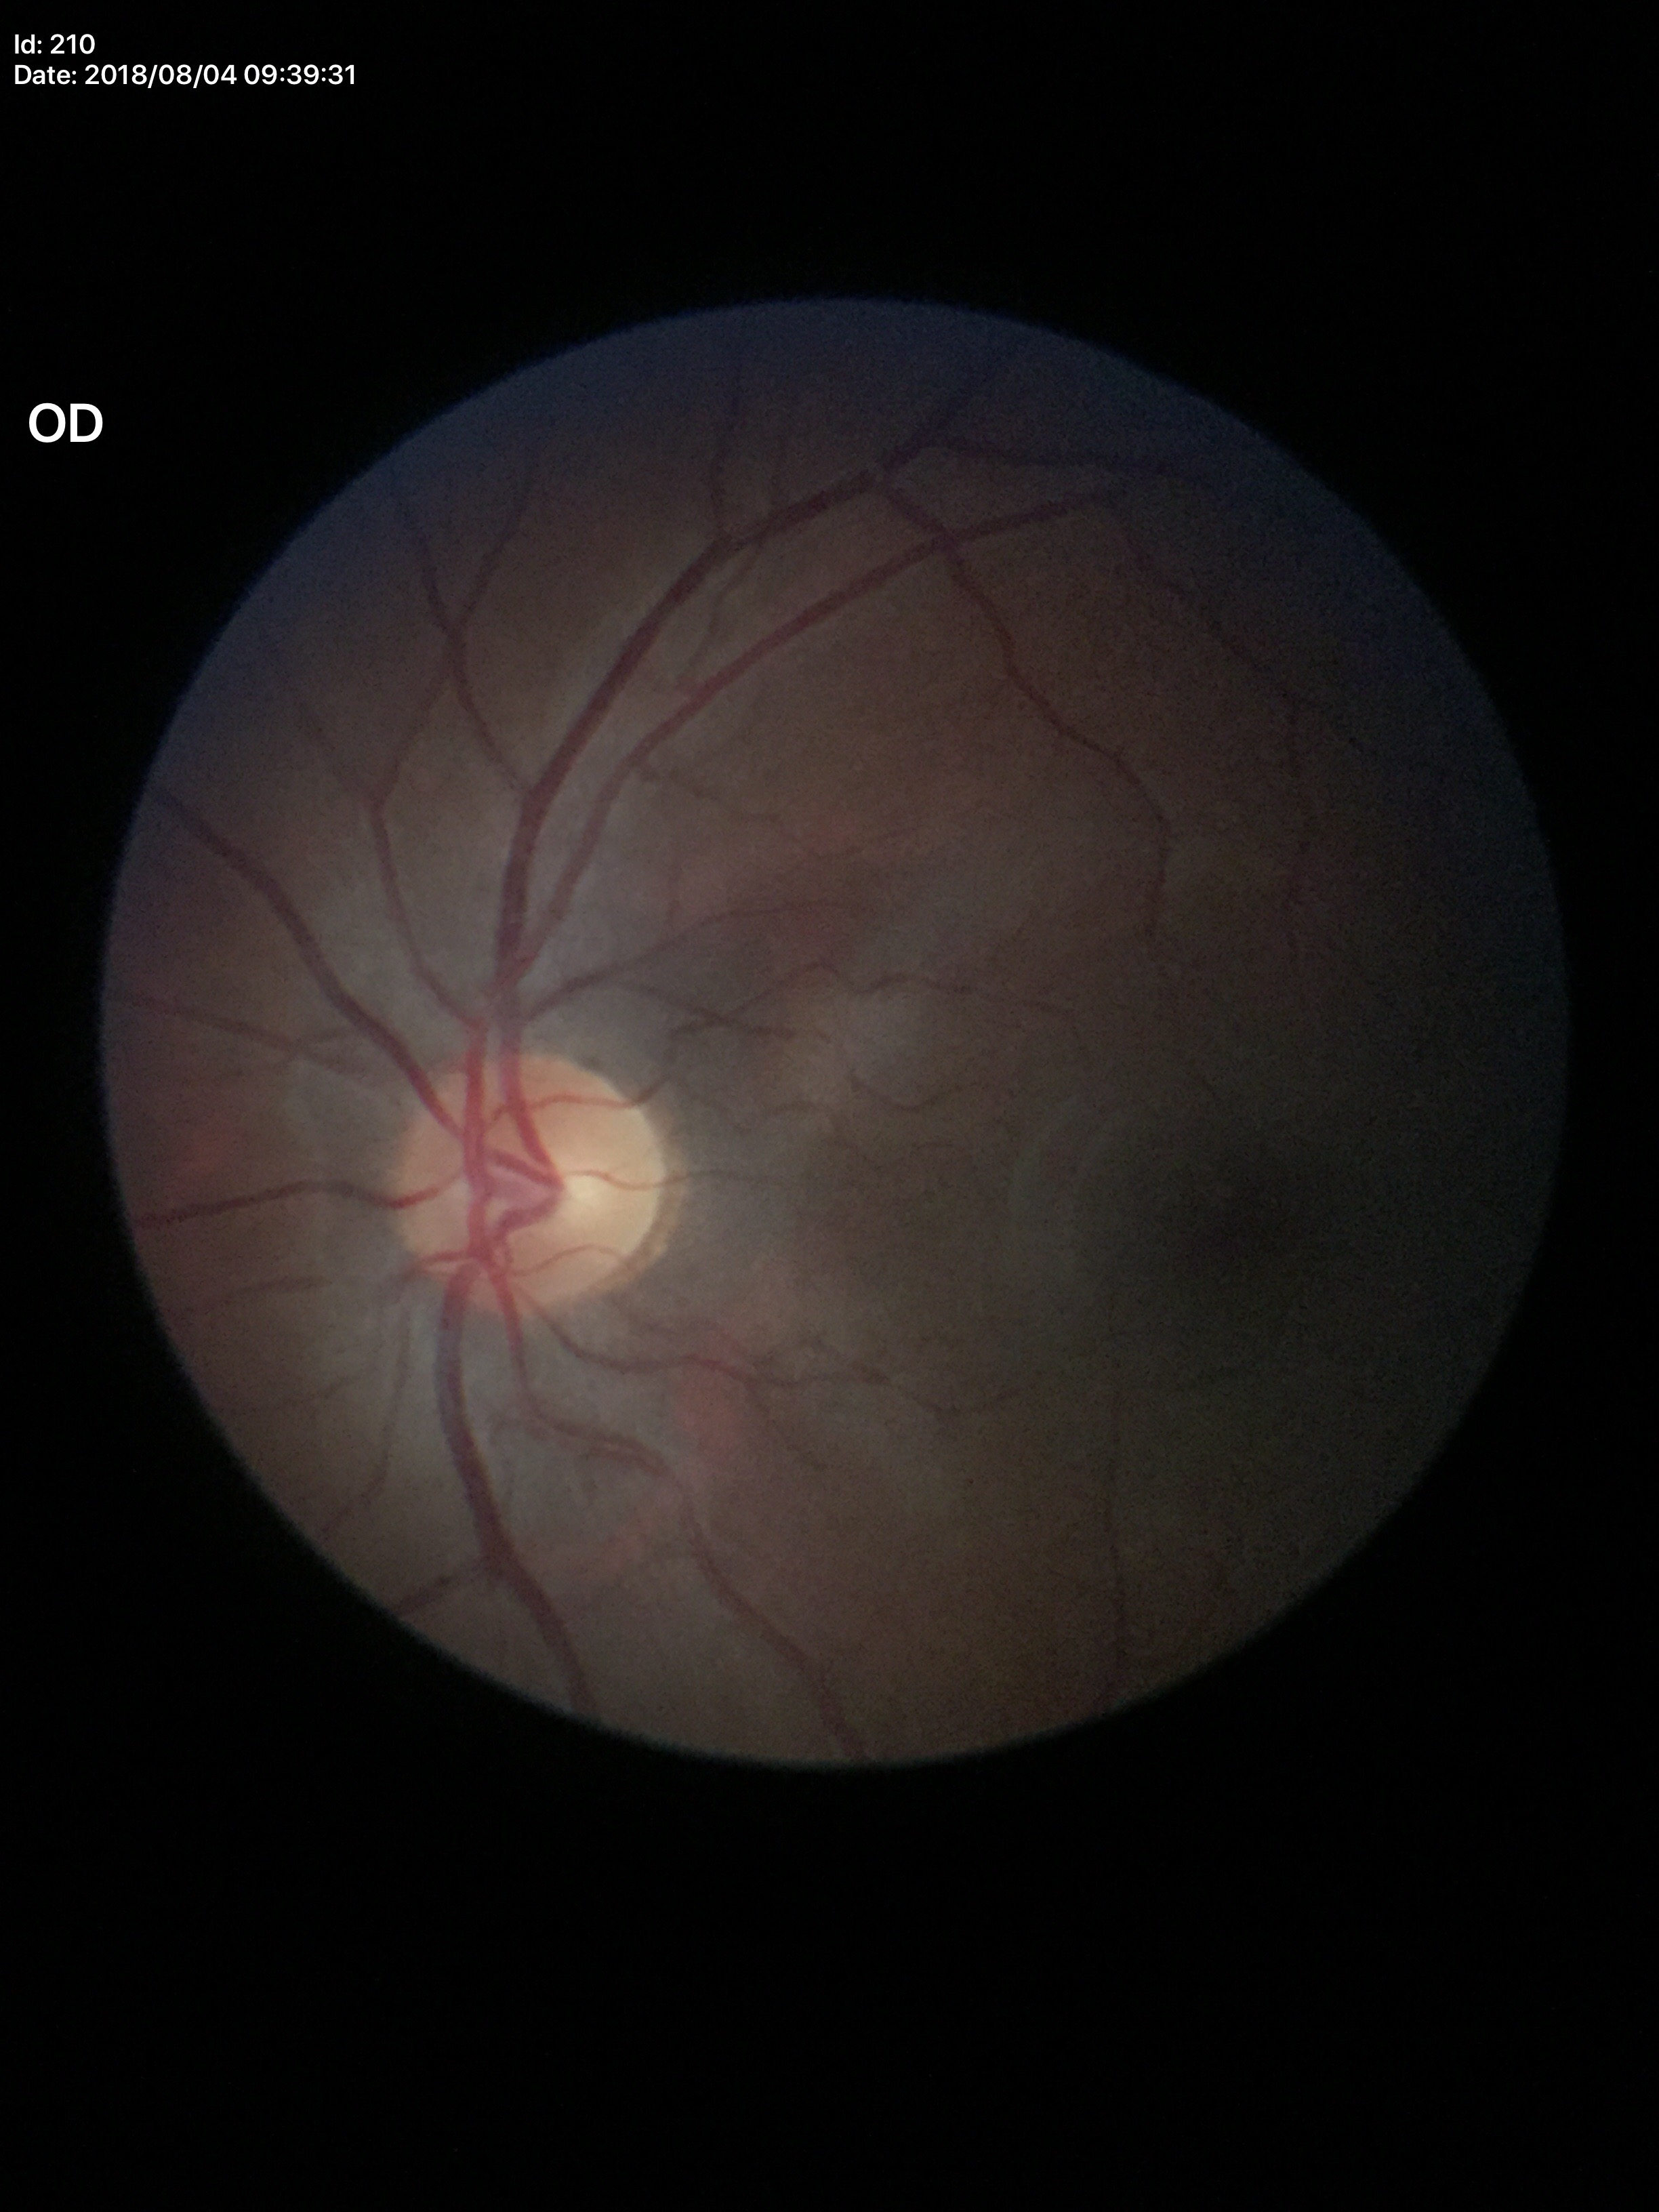

Glaucoma decision: negative.
Vertical cup-to-disc ratio (VCDR): 0.53.